Wide-field fundus image from infant ROP screening; 100° field of view (Phoenix ICON) — 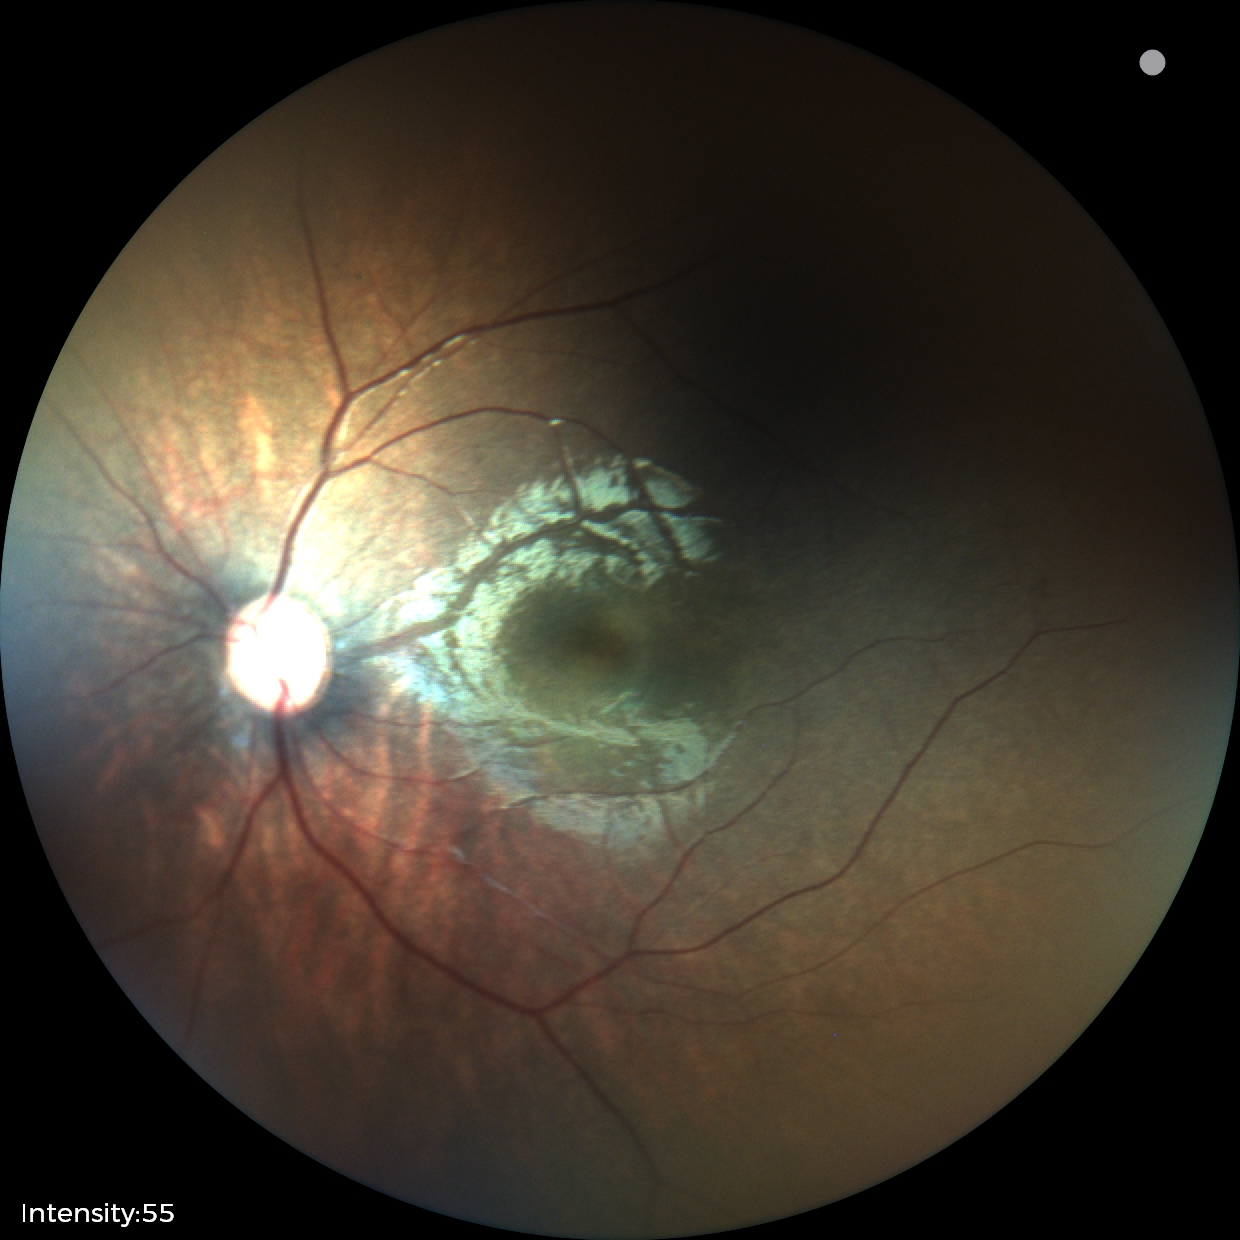 Diagnosis = normal retinal appearance.